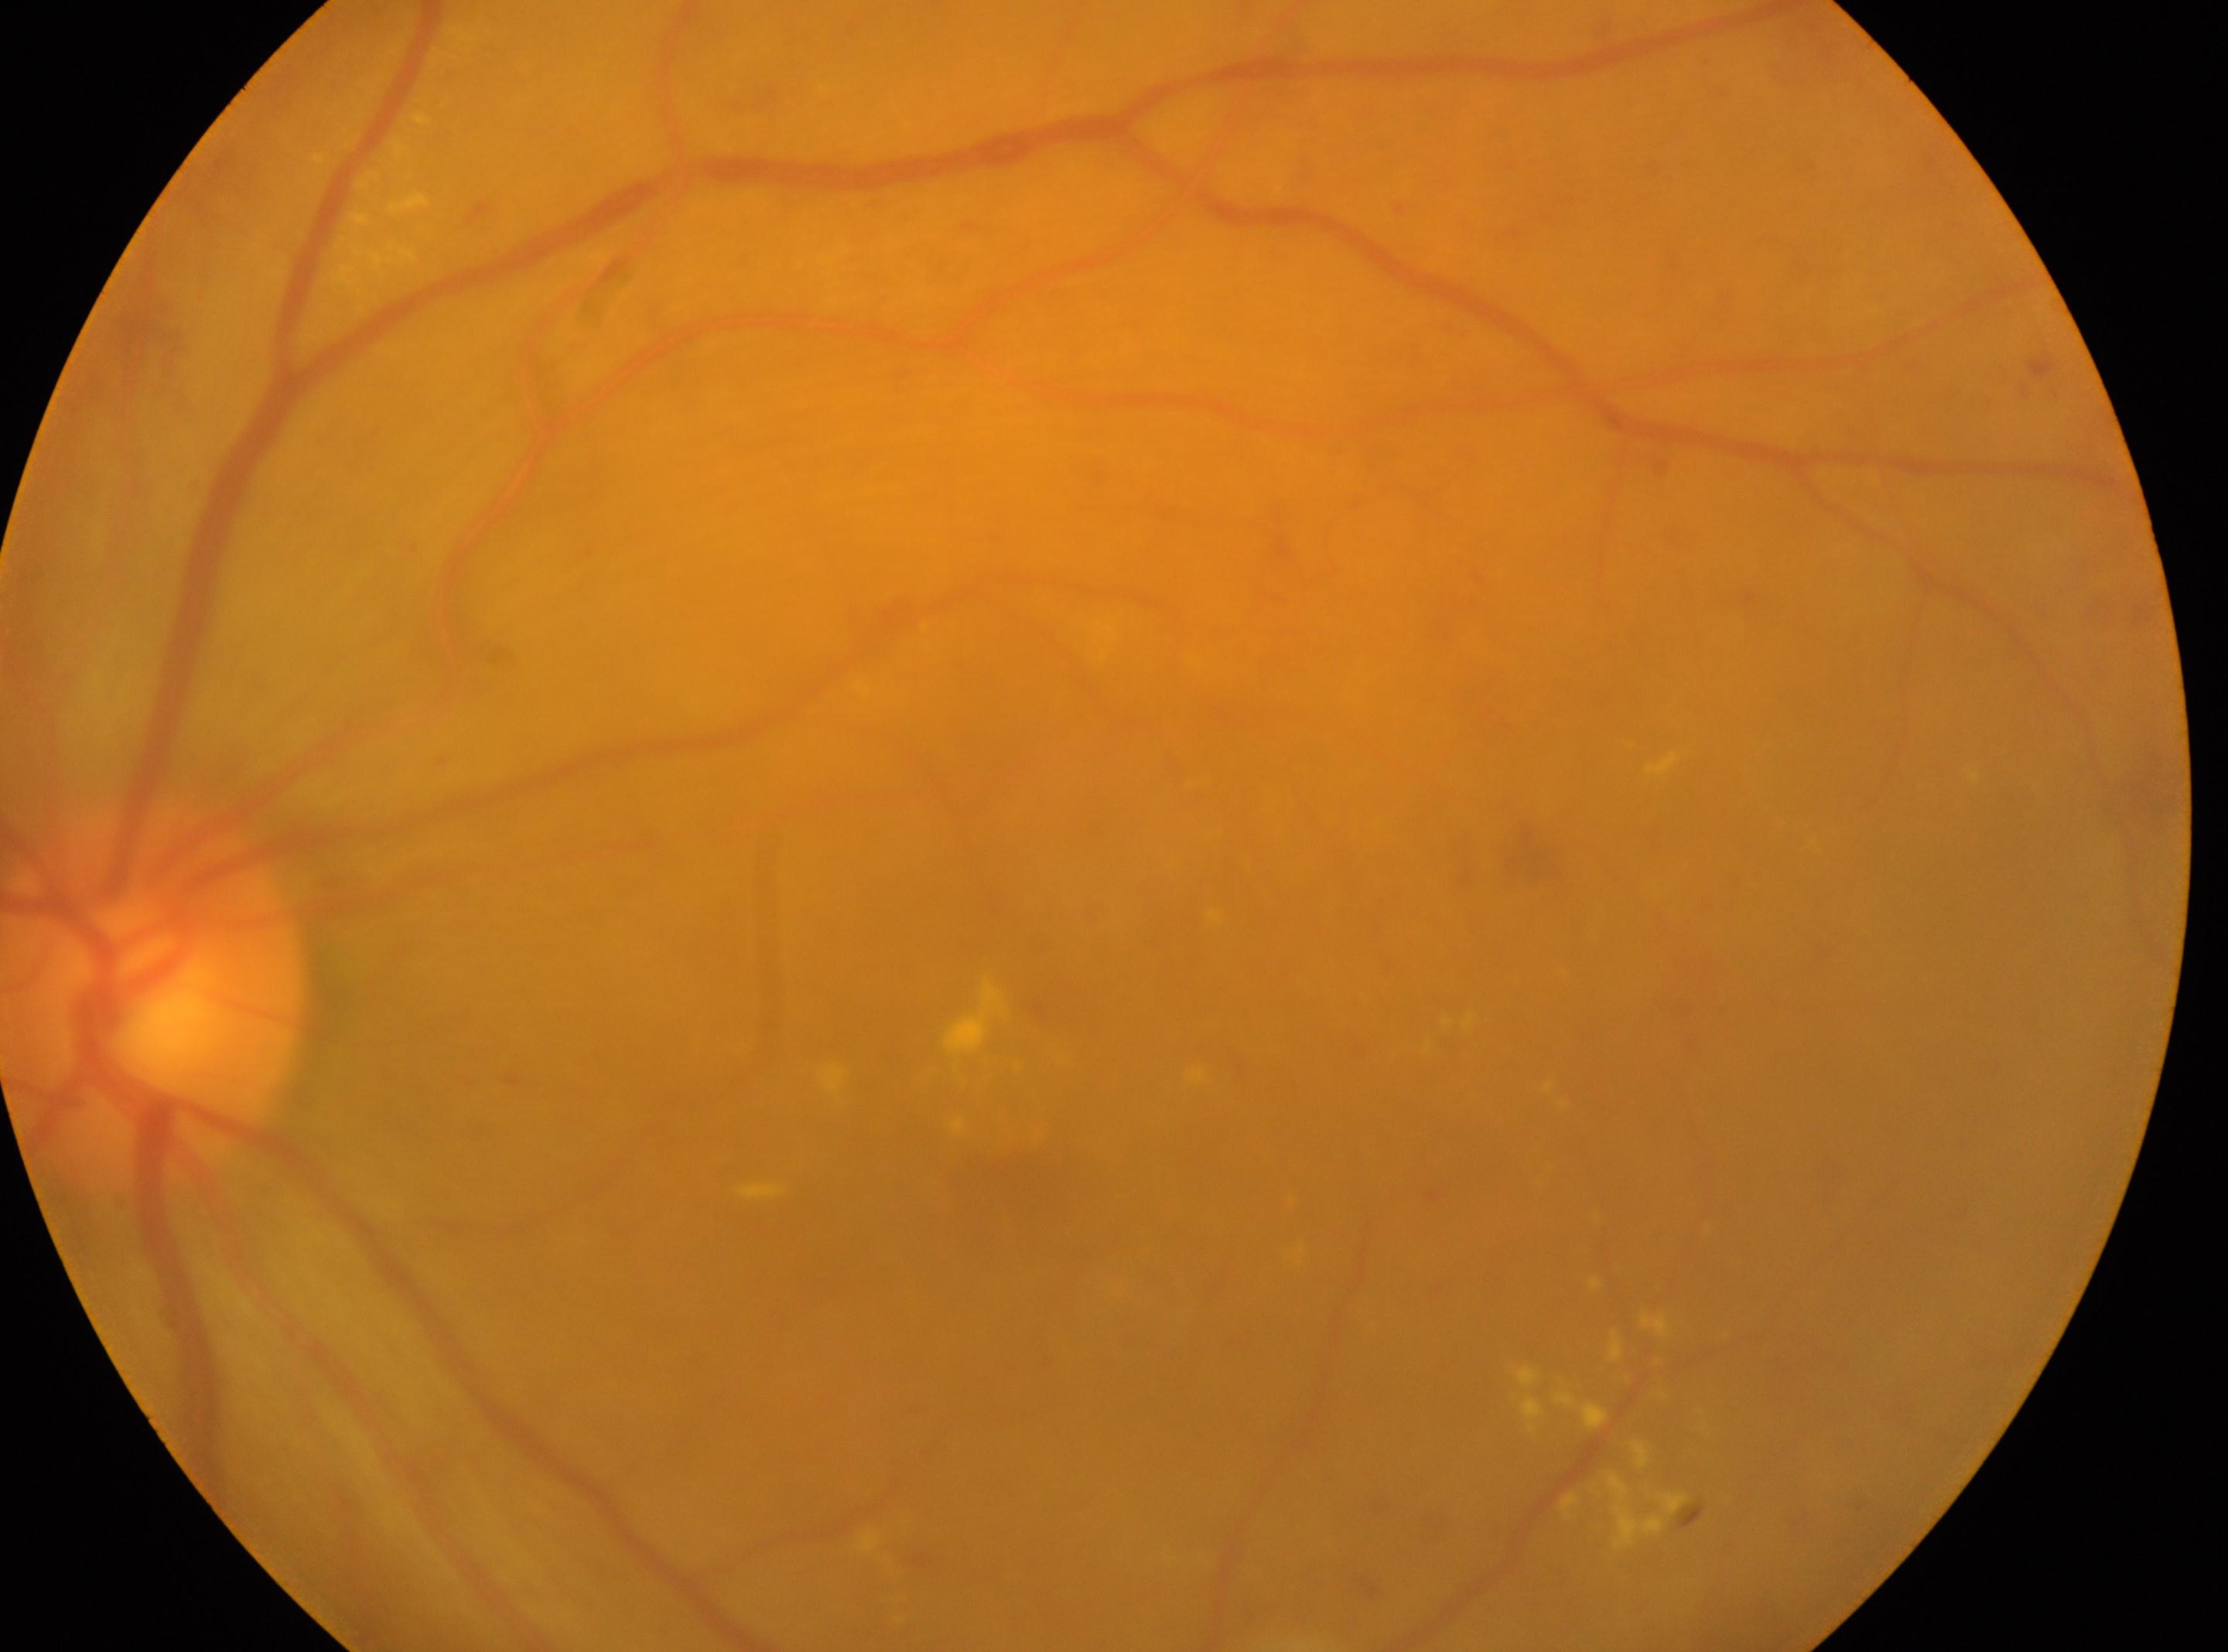 | field | value |
|---|---|
| optic disc | [155, 999] |
| foveal center | [998, 1168] |
| DR stage | moderate NPDR (grade 2) |
| laterality | oculus sinister |